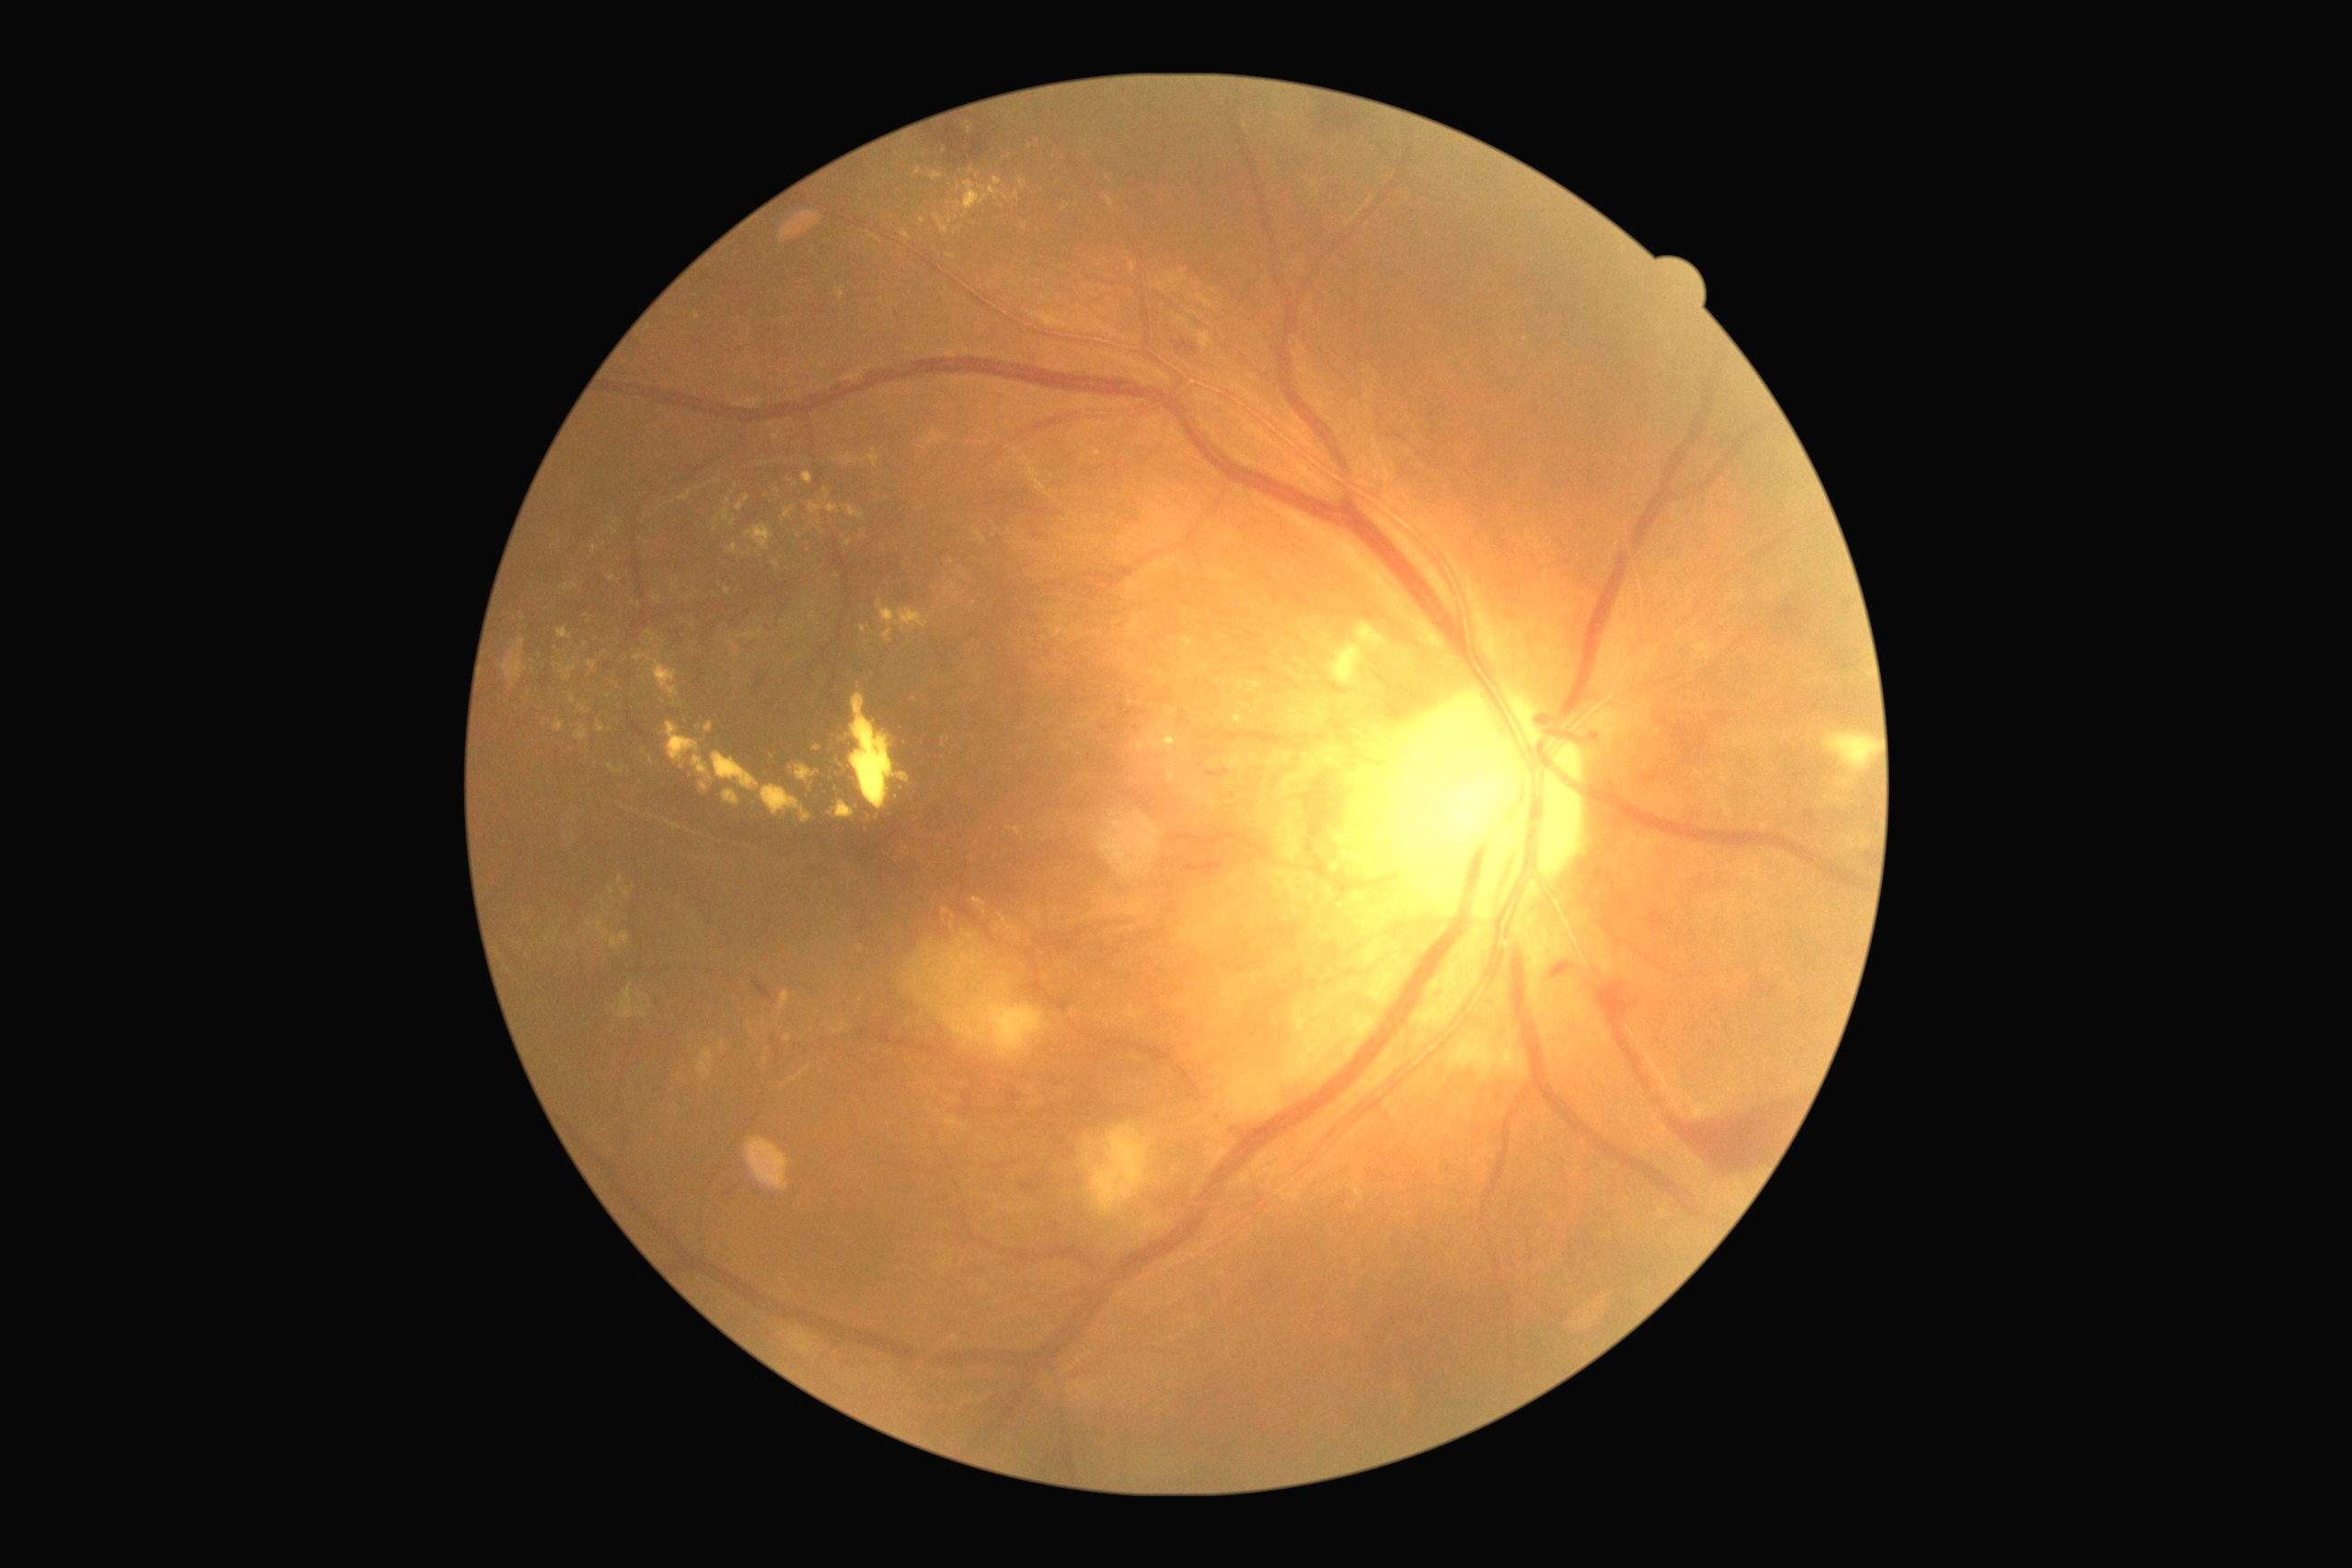

Diabetic retinopathy: 4.
Hard exudates (partial list) at Rect(1099, 260, 1104, 268); Rect(721, 509, 736, 525); Rect(578, 705, 593, 716); Rect(961, 930, 975, 943); Rect(1295, 890, 1302, 903); Rect(596, 723, 605, 734); Rect(957, 179, 1003, 213); Rect(916, 166, 923, 175); Rect(796, 765, 821, 783); Rect(727, 544, 738, 554); Rect(1315, 910, 1322, 921); Rect(672, 580, 678, 589); Rect(790, 1066, 810, 1083).
Small hard exudates approximately at pt(585, 645); pt(746, 554); pt(1065, 208); pt(612, 893); pt(777, 491).